Camera: Nidek AFC-330.
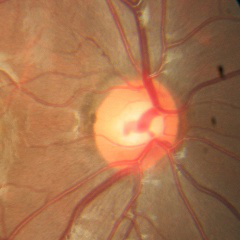 Glaucoma assessment: no glaucomatous optic neuropathy.